Camera: Phoenix ICON (100° FOV). 1240 by 1240 pixels. Wide-field fundus image from infant ROP screening.
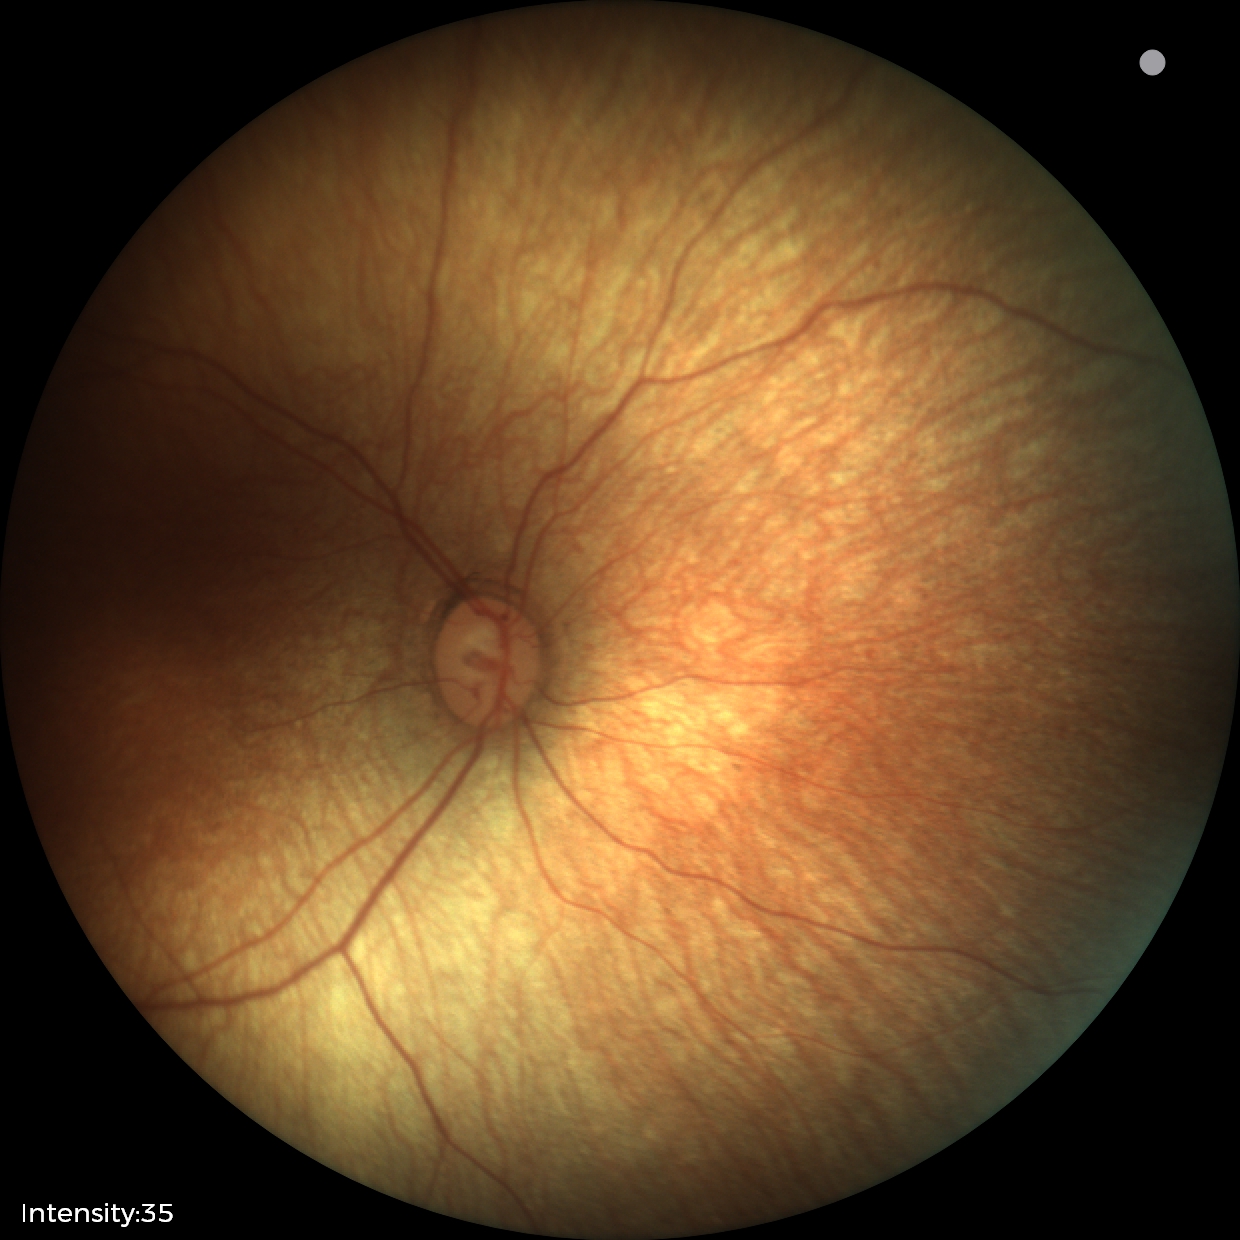 Screening examination with no abnormal retinal findings.